Captured with pupil dilation · captured on a Topcon TRC retinal camera · optic disc photograph.
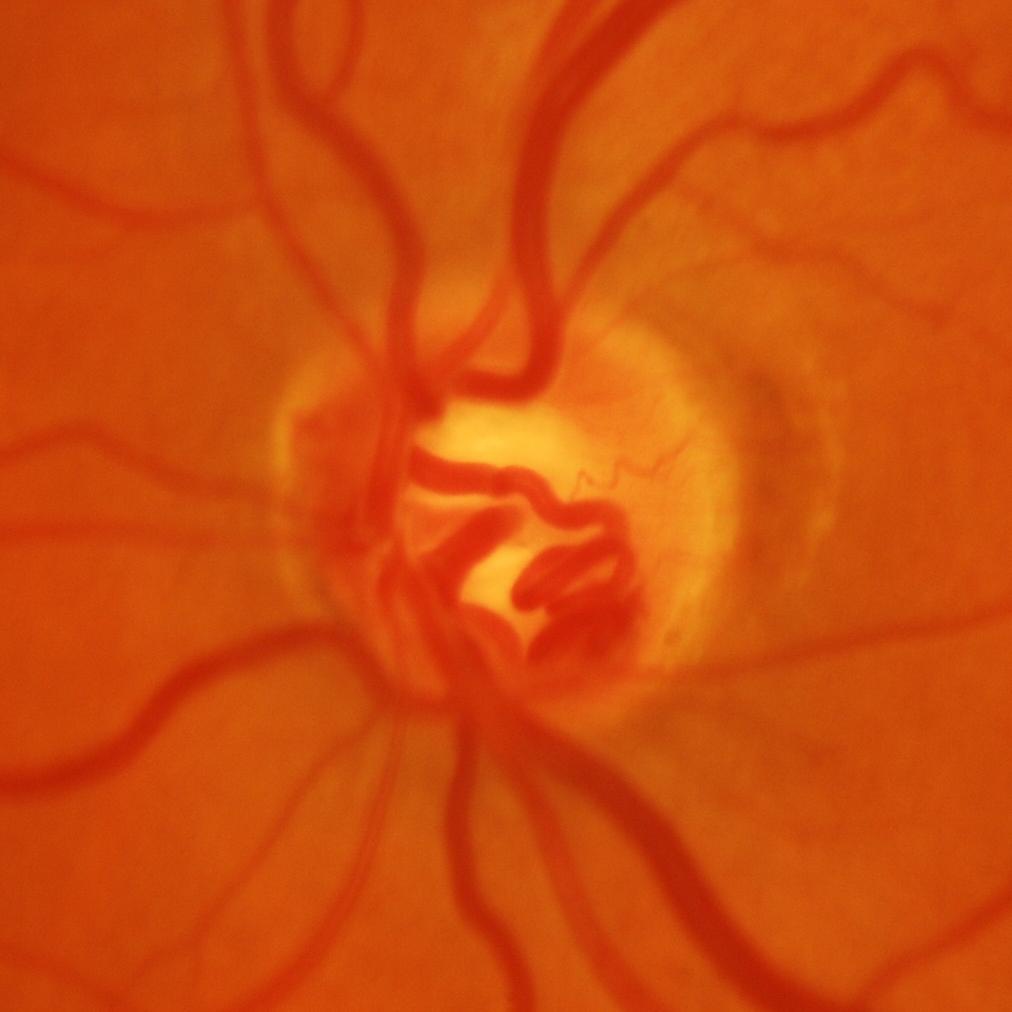

Diagnosis: glaucomatous findings.